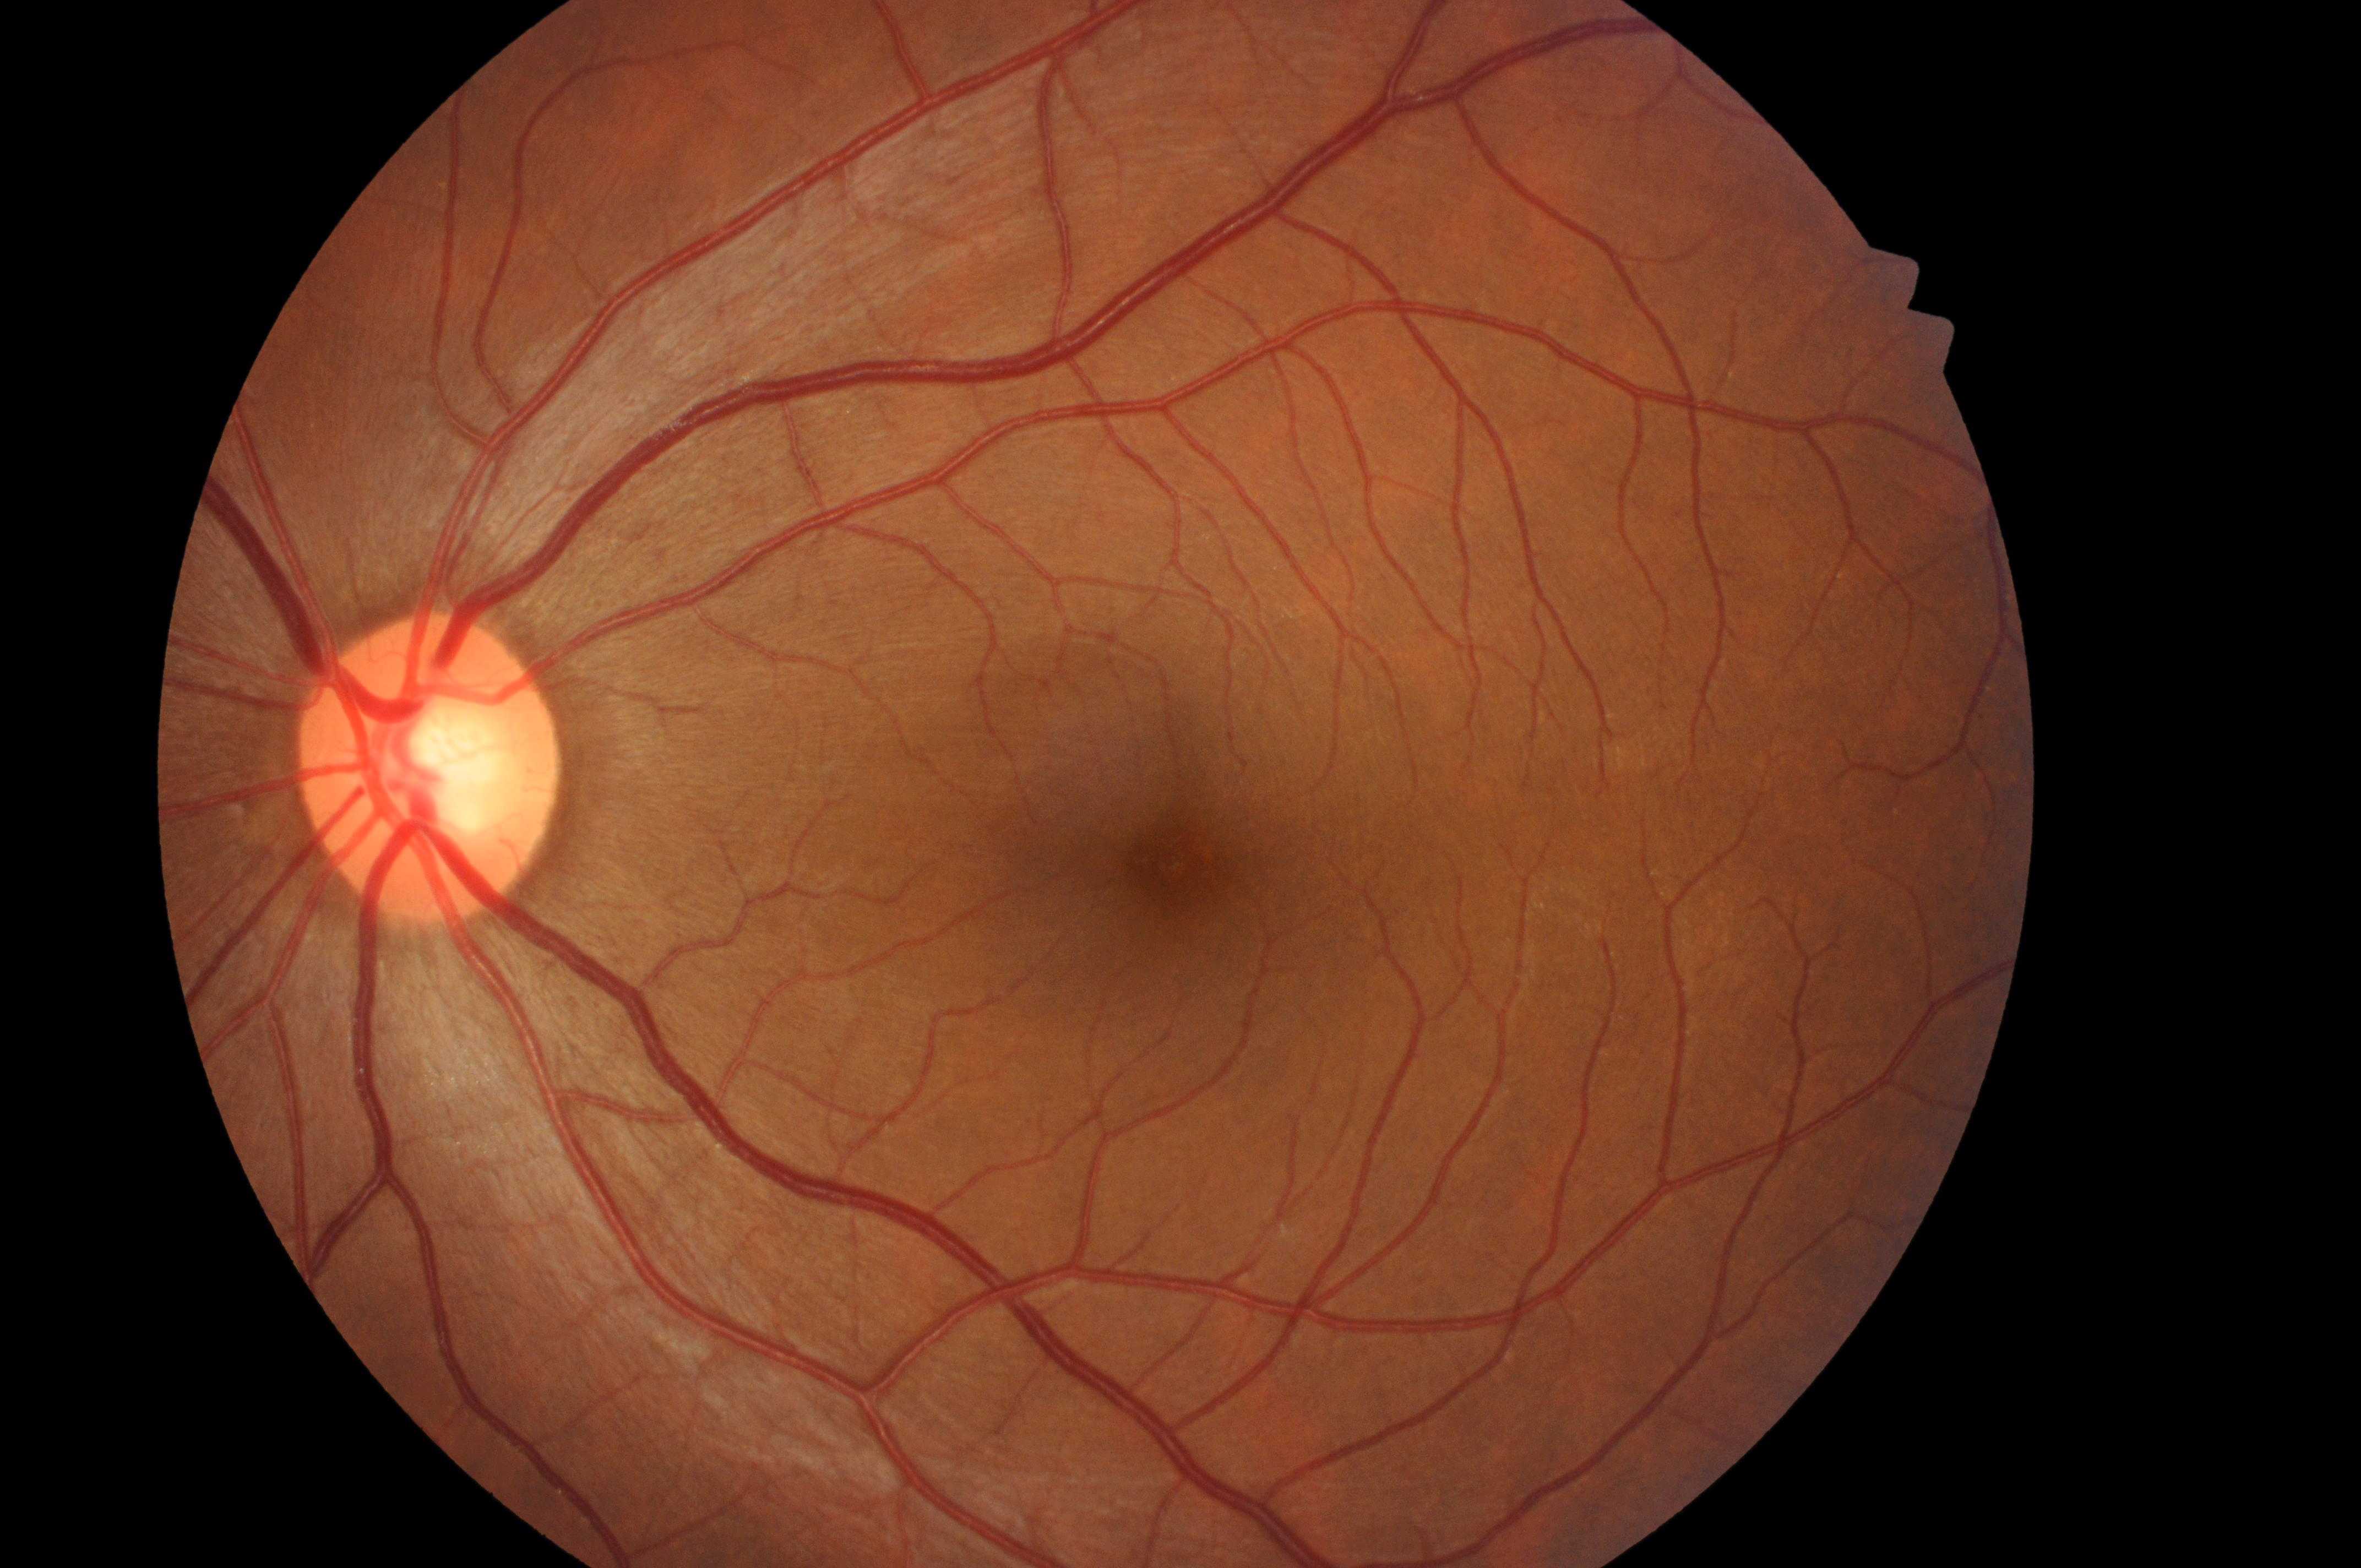

Diabetic macular edema: grade 0 (no risk).
Macula center: (1184,866).
Retinopathy grade is no apparent diabetic retinopathy (0).
The image shows the left eye.
Disc center located at (422,775).